Wide-field fundus photograph of an infant · acquired on the Phoenix ICON: 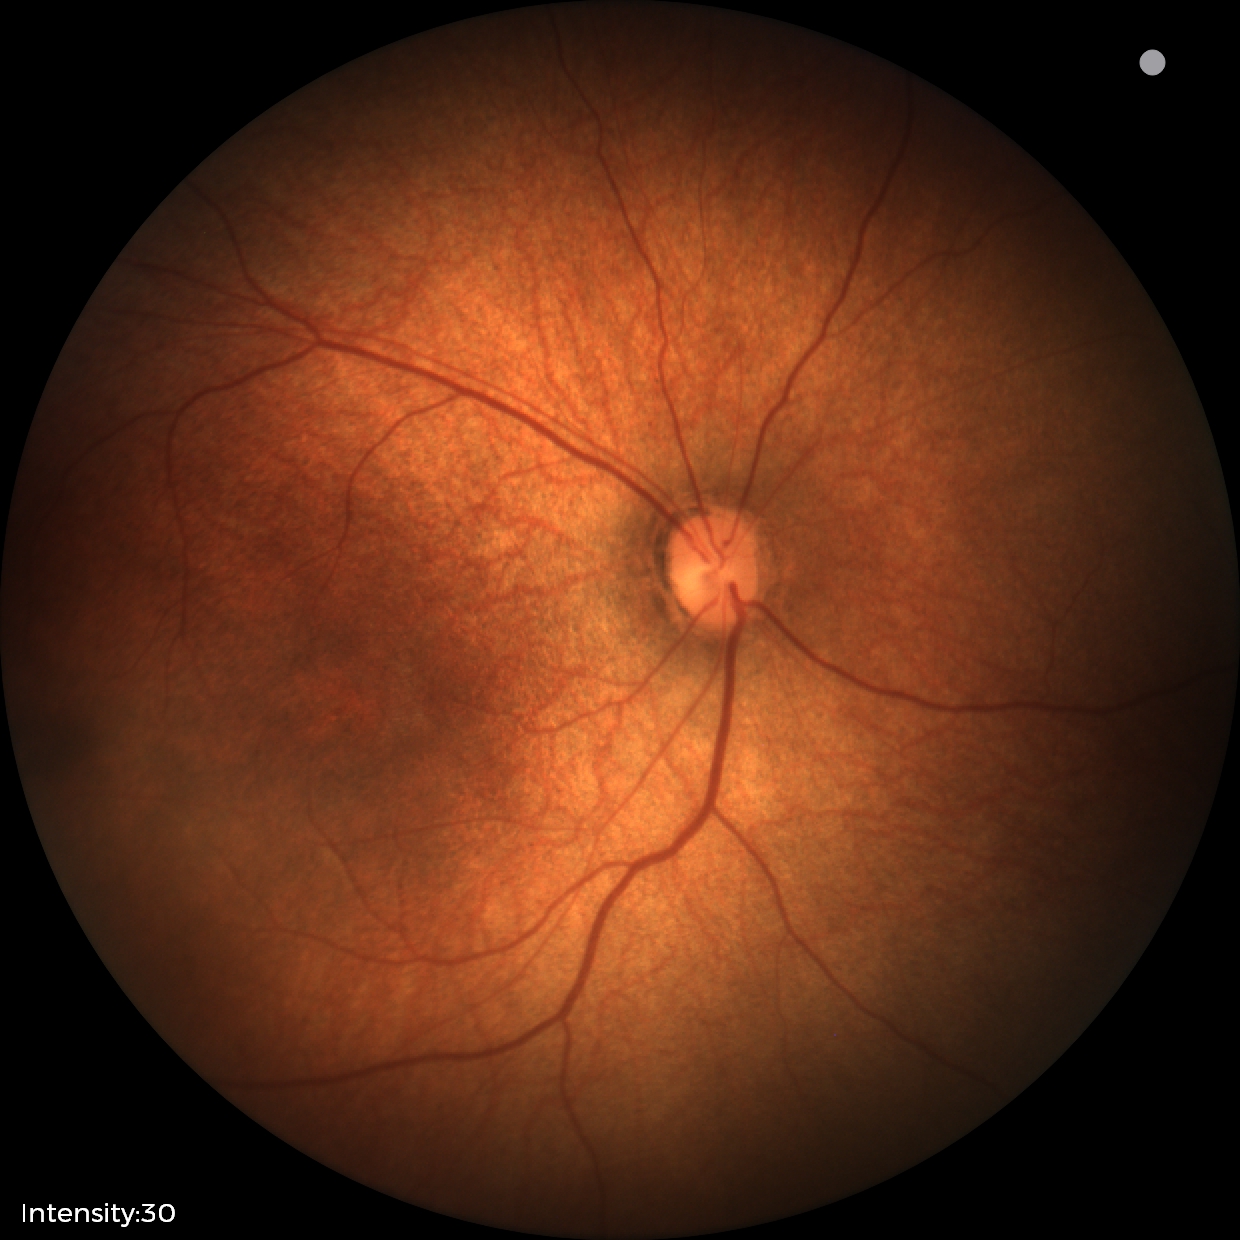 Physiological retinal appearance for postconceptual age.